NIDEK AFC-230.
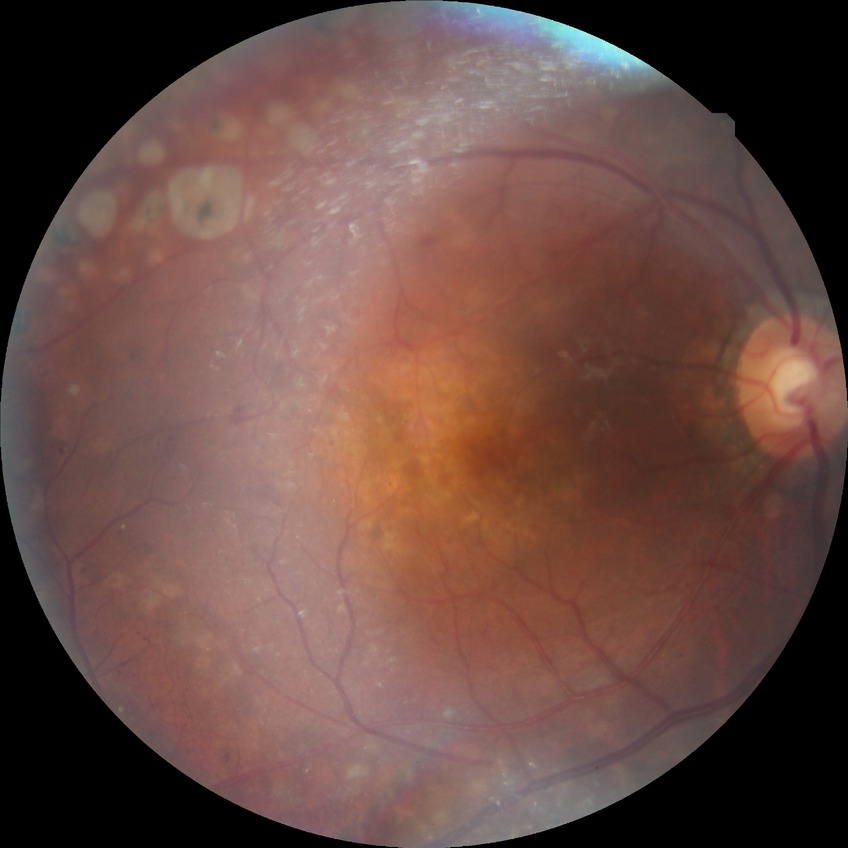 Davis stage: PDR.